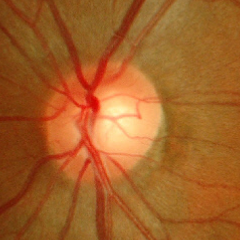 Glaucoma status = early glaucomatous optic neuropathy.